Color fundus photograph. 1932x1910px: 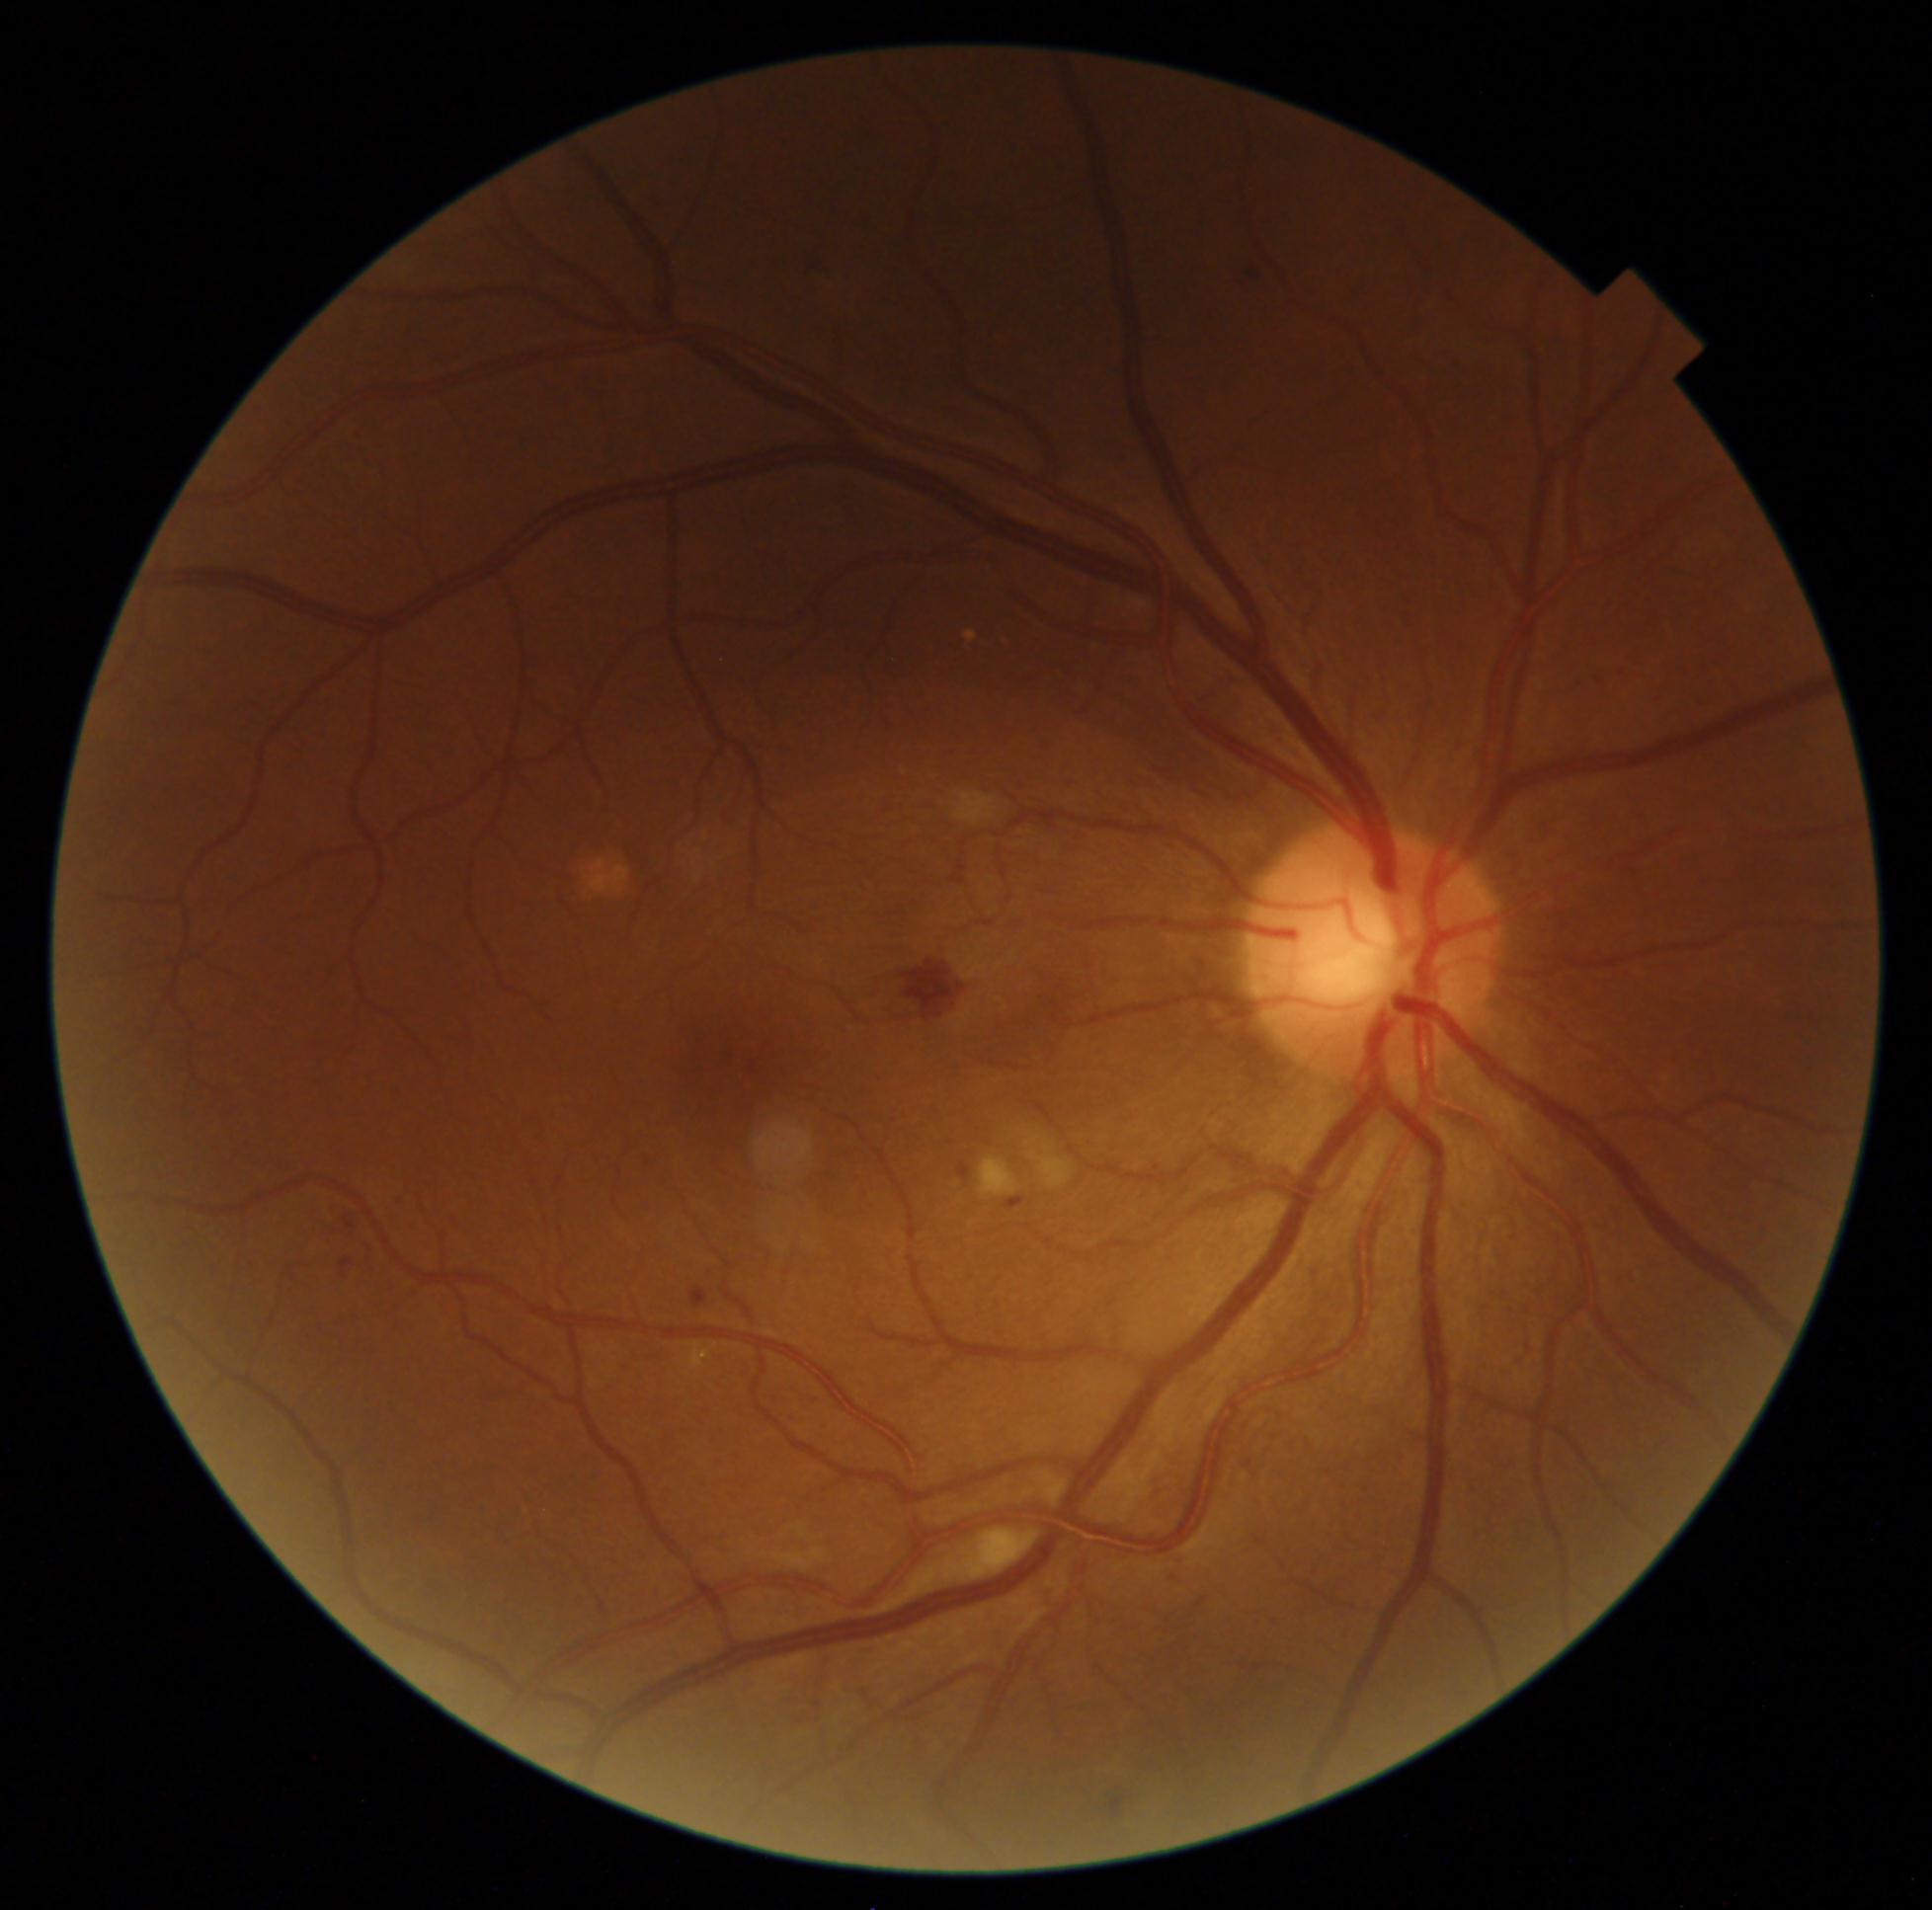 – diabetic retinopathy severity — 2/4